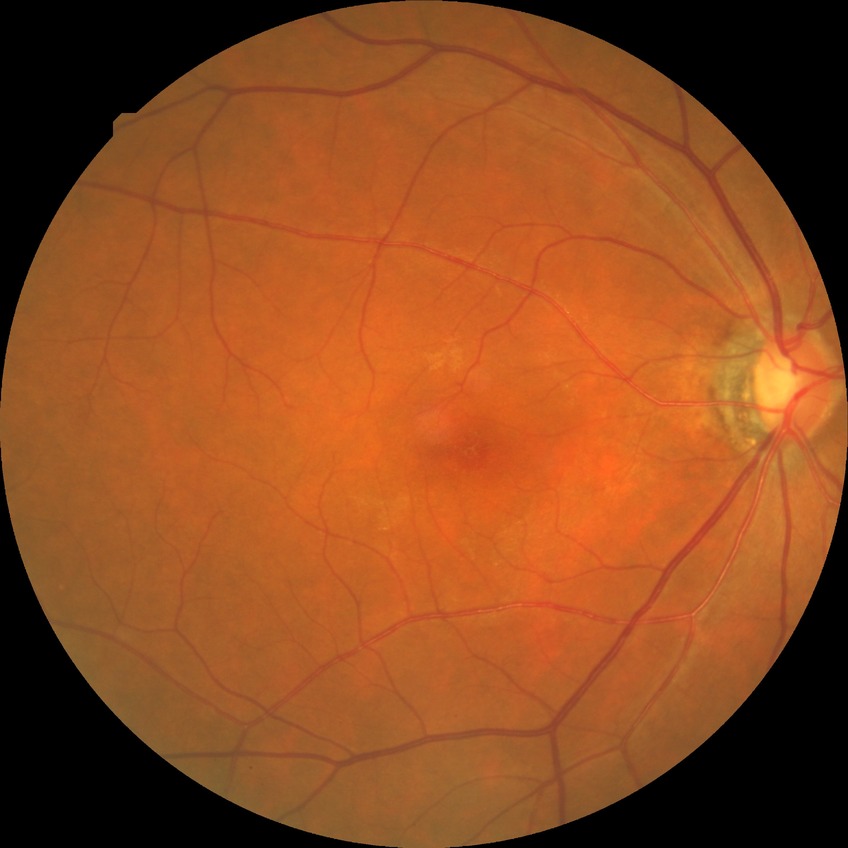
Assessment:
* diabetic retinopathy (DR) — no diabetic retinopathy (NDR)